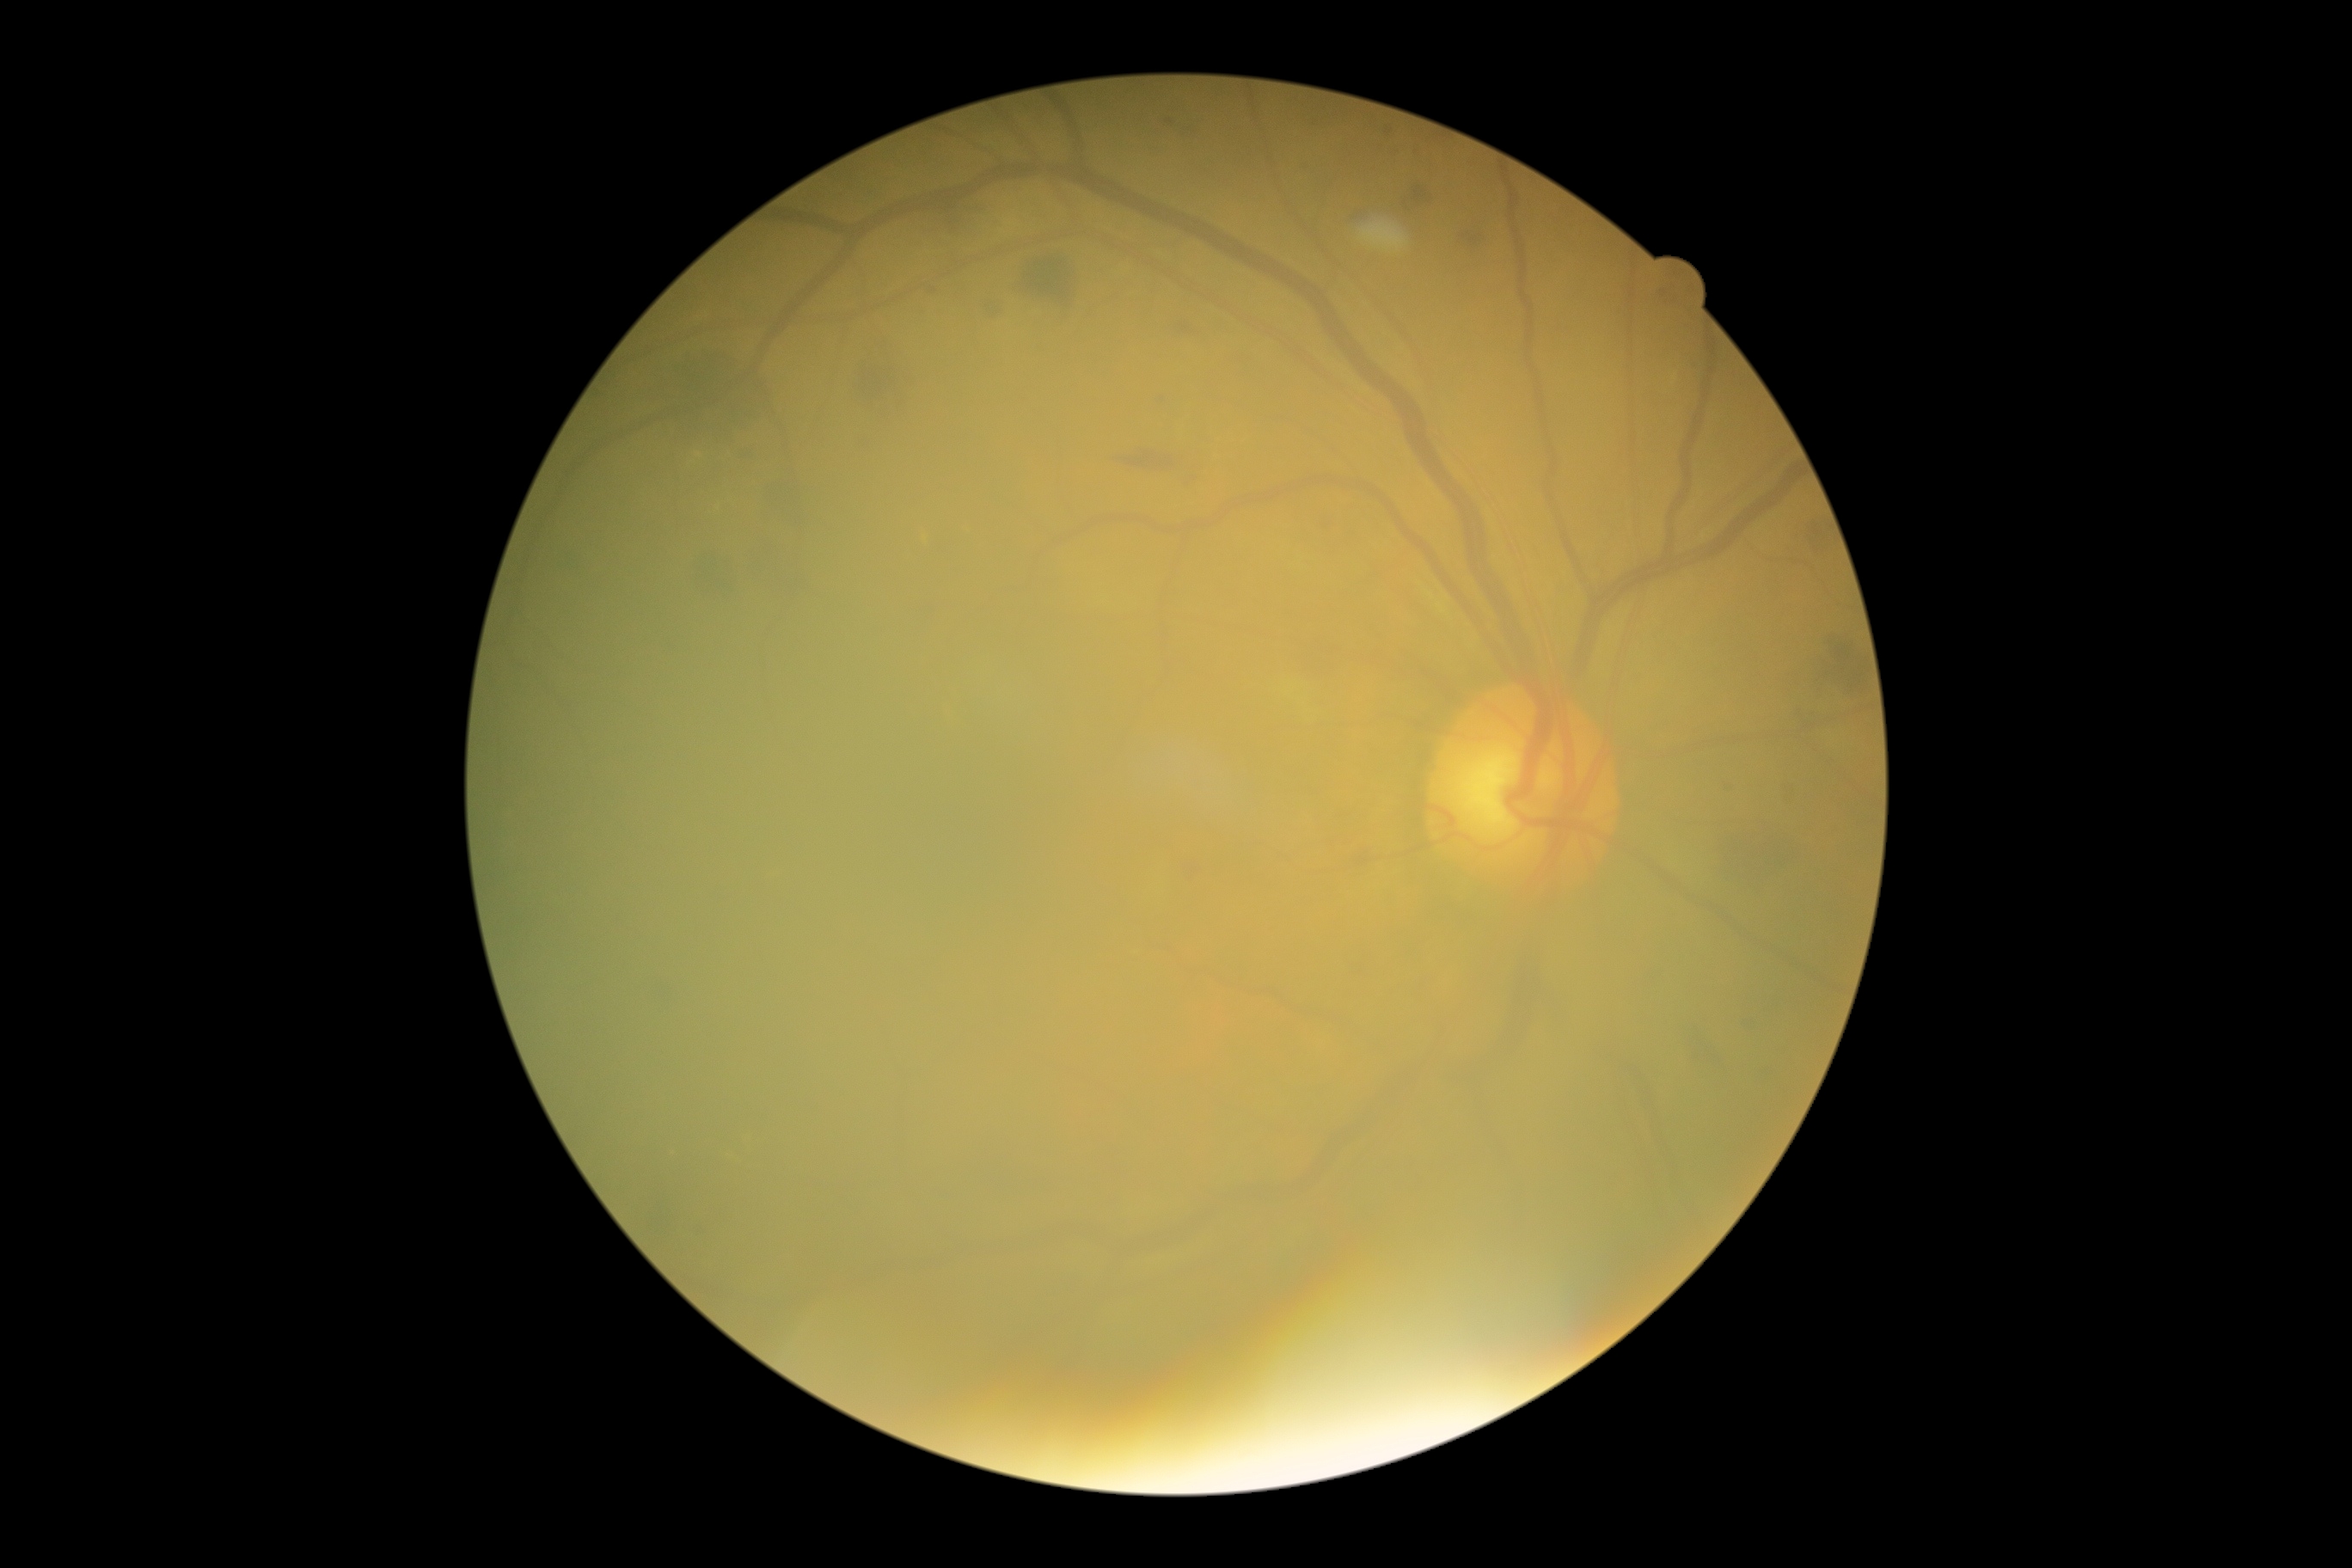

diabetic retinopathy severity = grade 2 (moderate NPDR) — more than just microaneurysms but less than severe NPDR.